1659 by 2212 pixels; camera: Remidio smartphone fundus camera
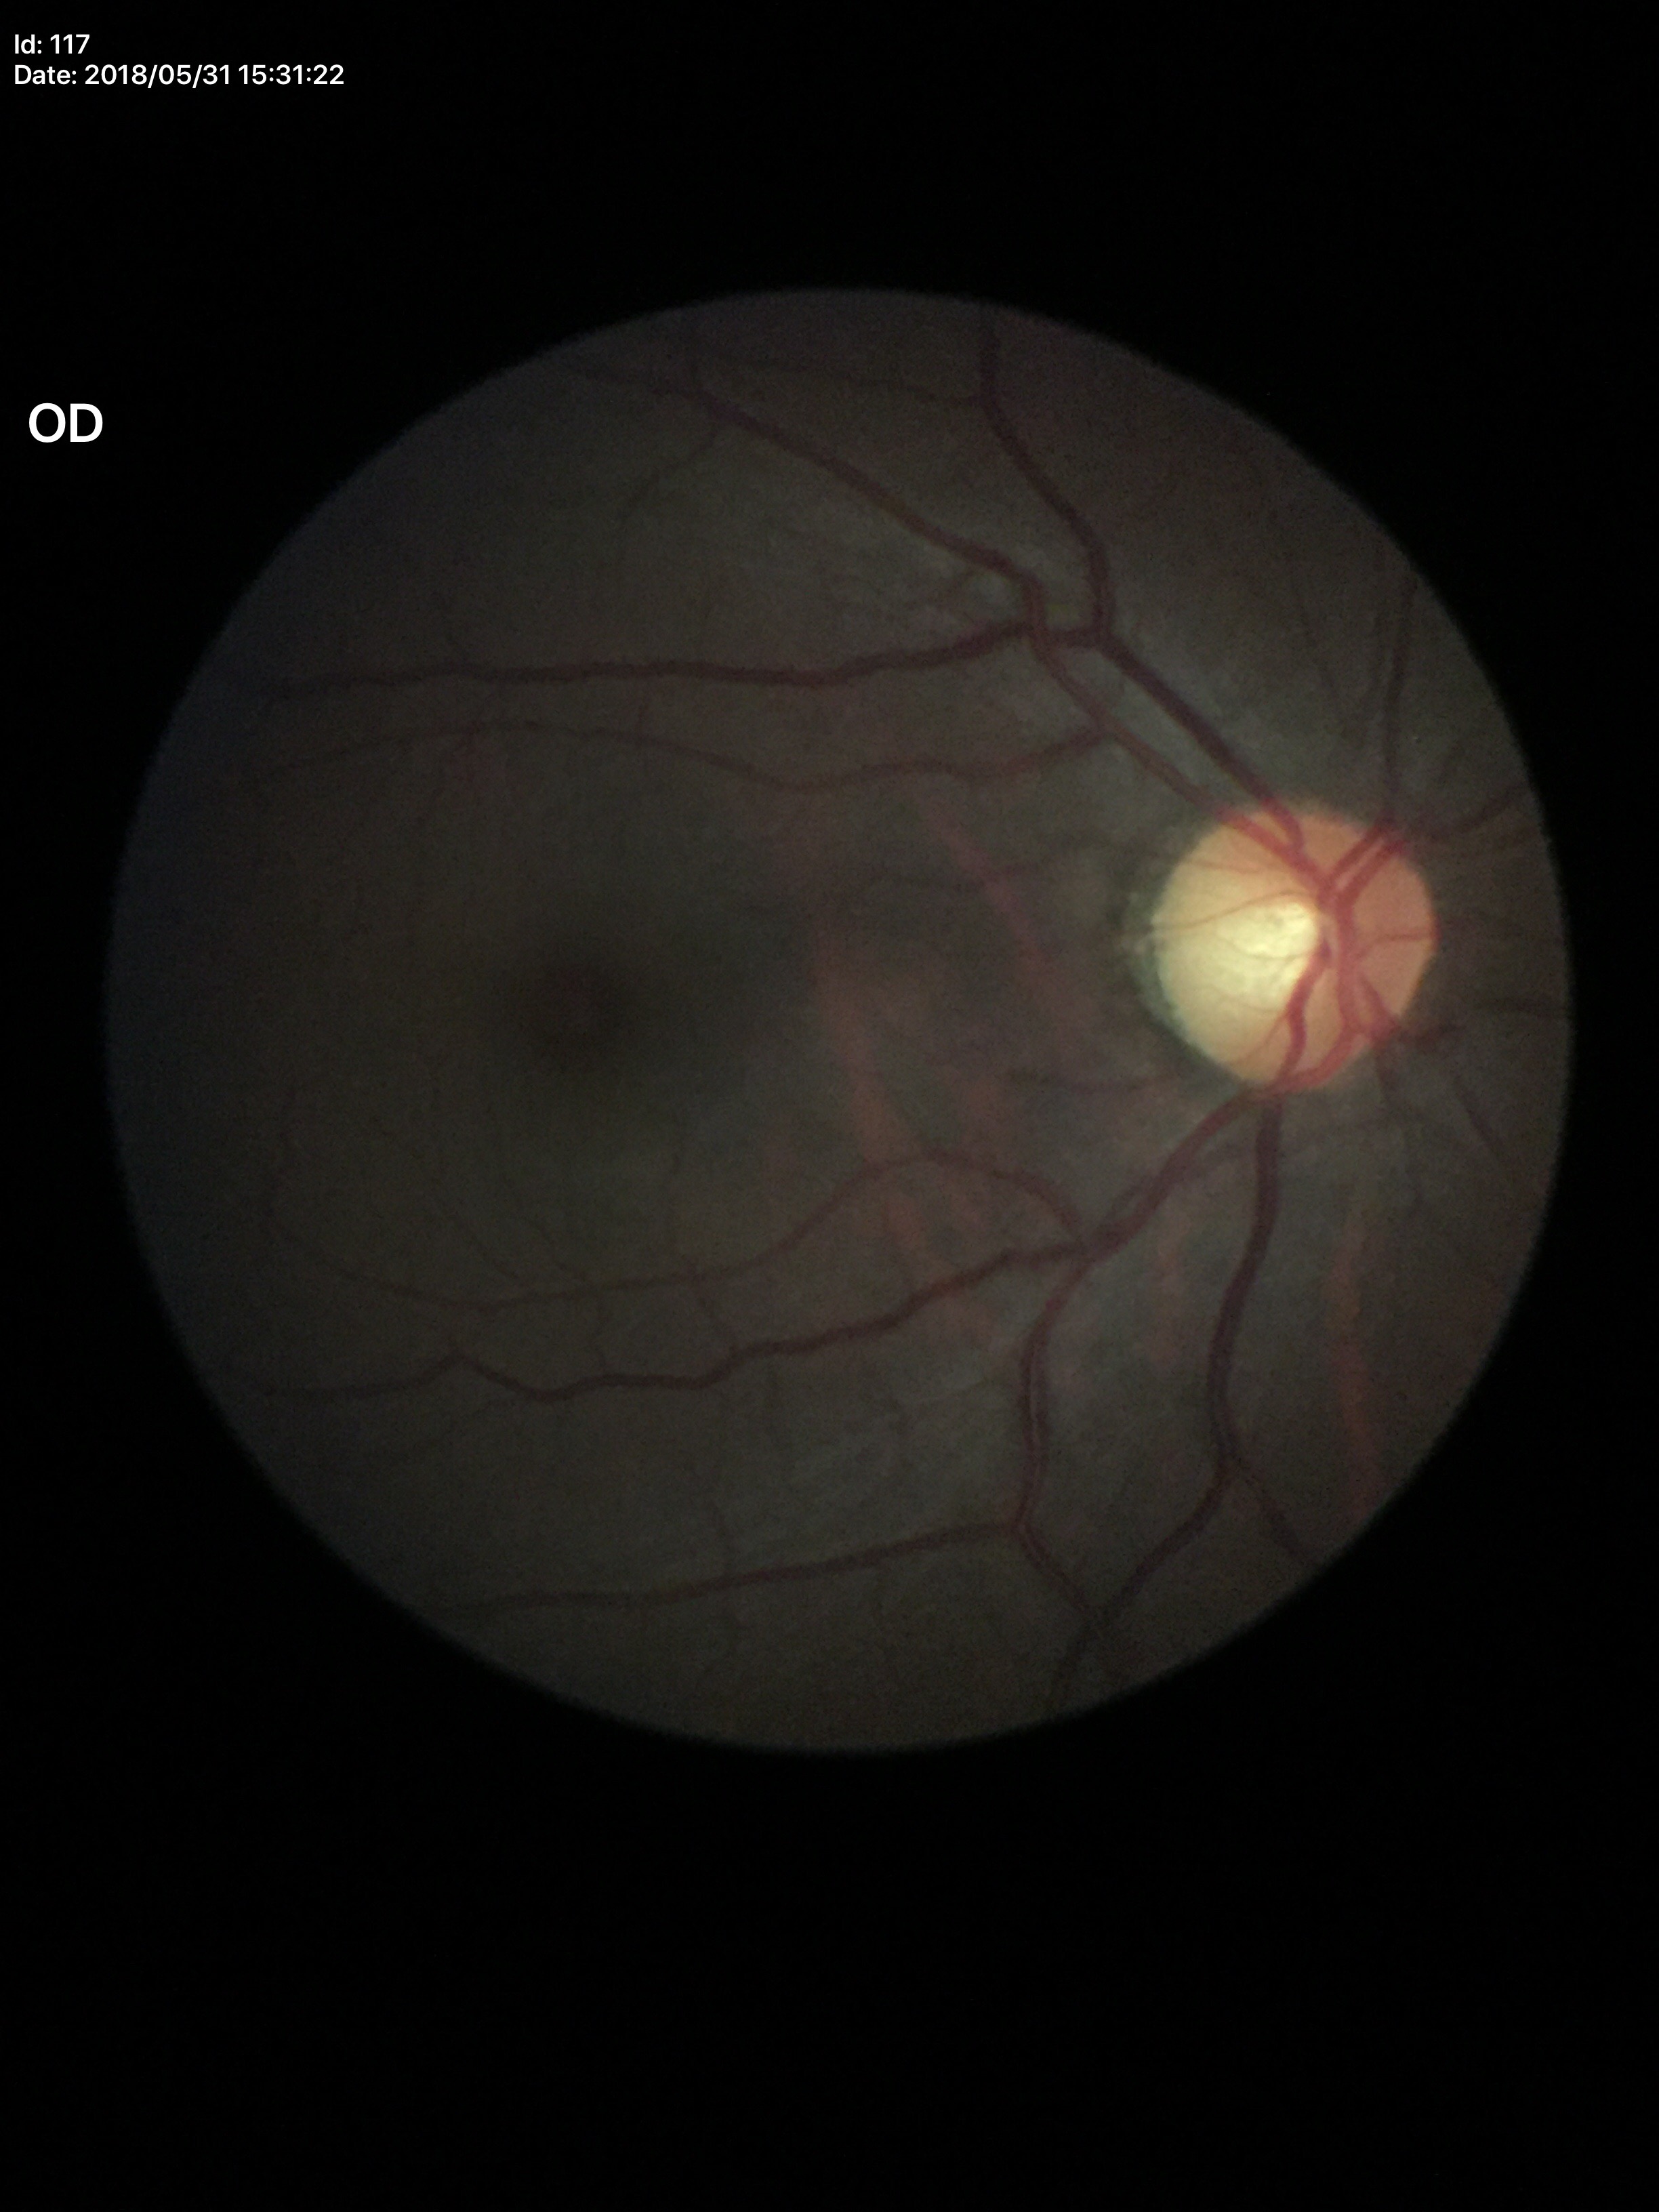 Negative for glaucoma suspicion.
Vertical cup-disc ratio: 0.52.